640x480px · infant wide-field fundus photograph · acquired on the Clarity RetCam 3: 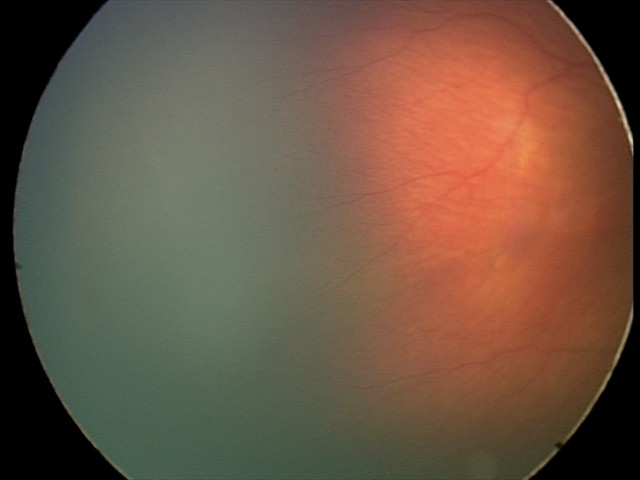

Without plus disease.
Examination diagnosed as ROP stage 2.